Color fundus photograph. 45° FOV.
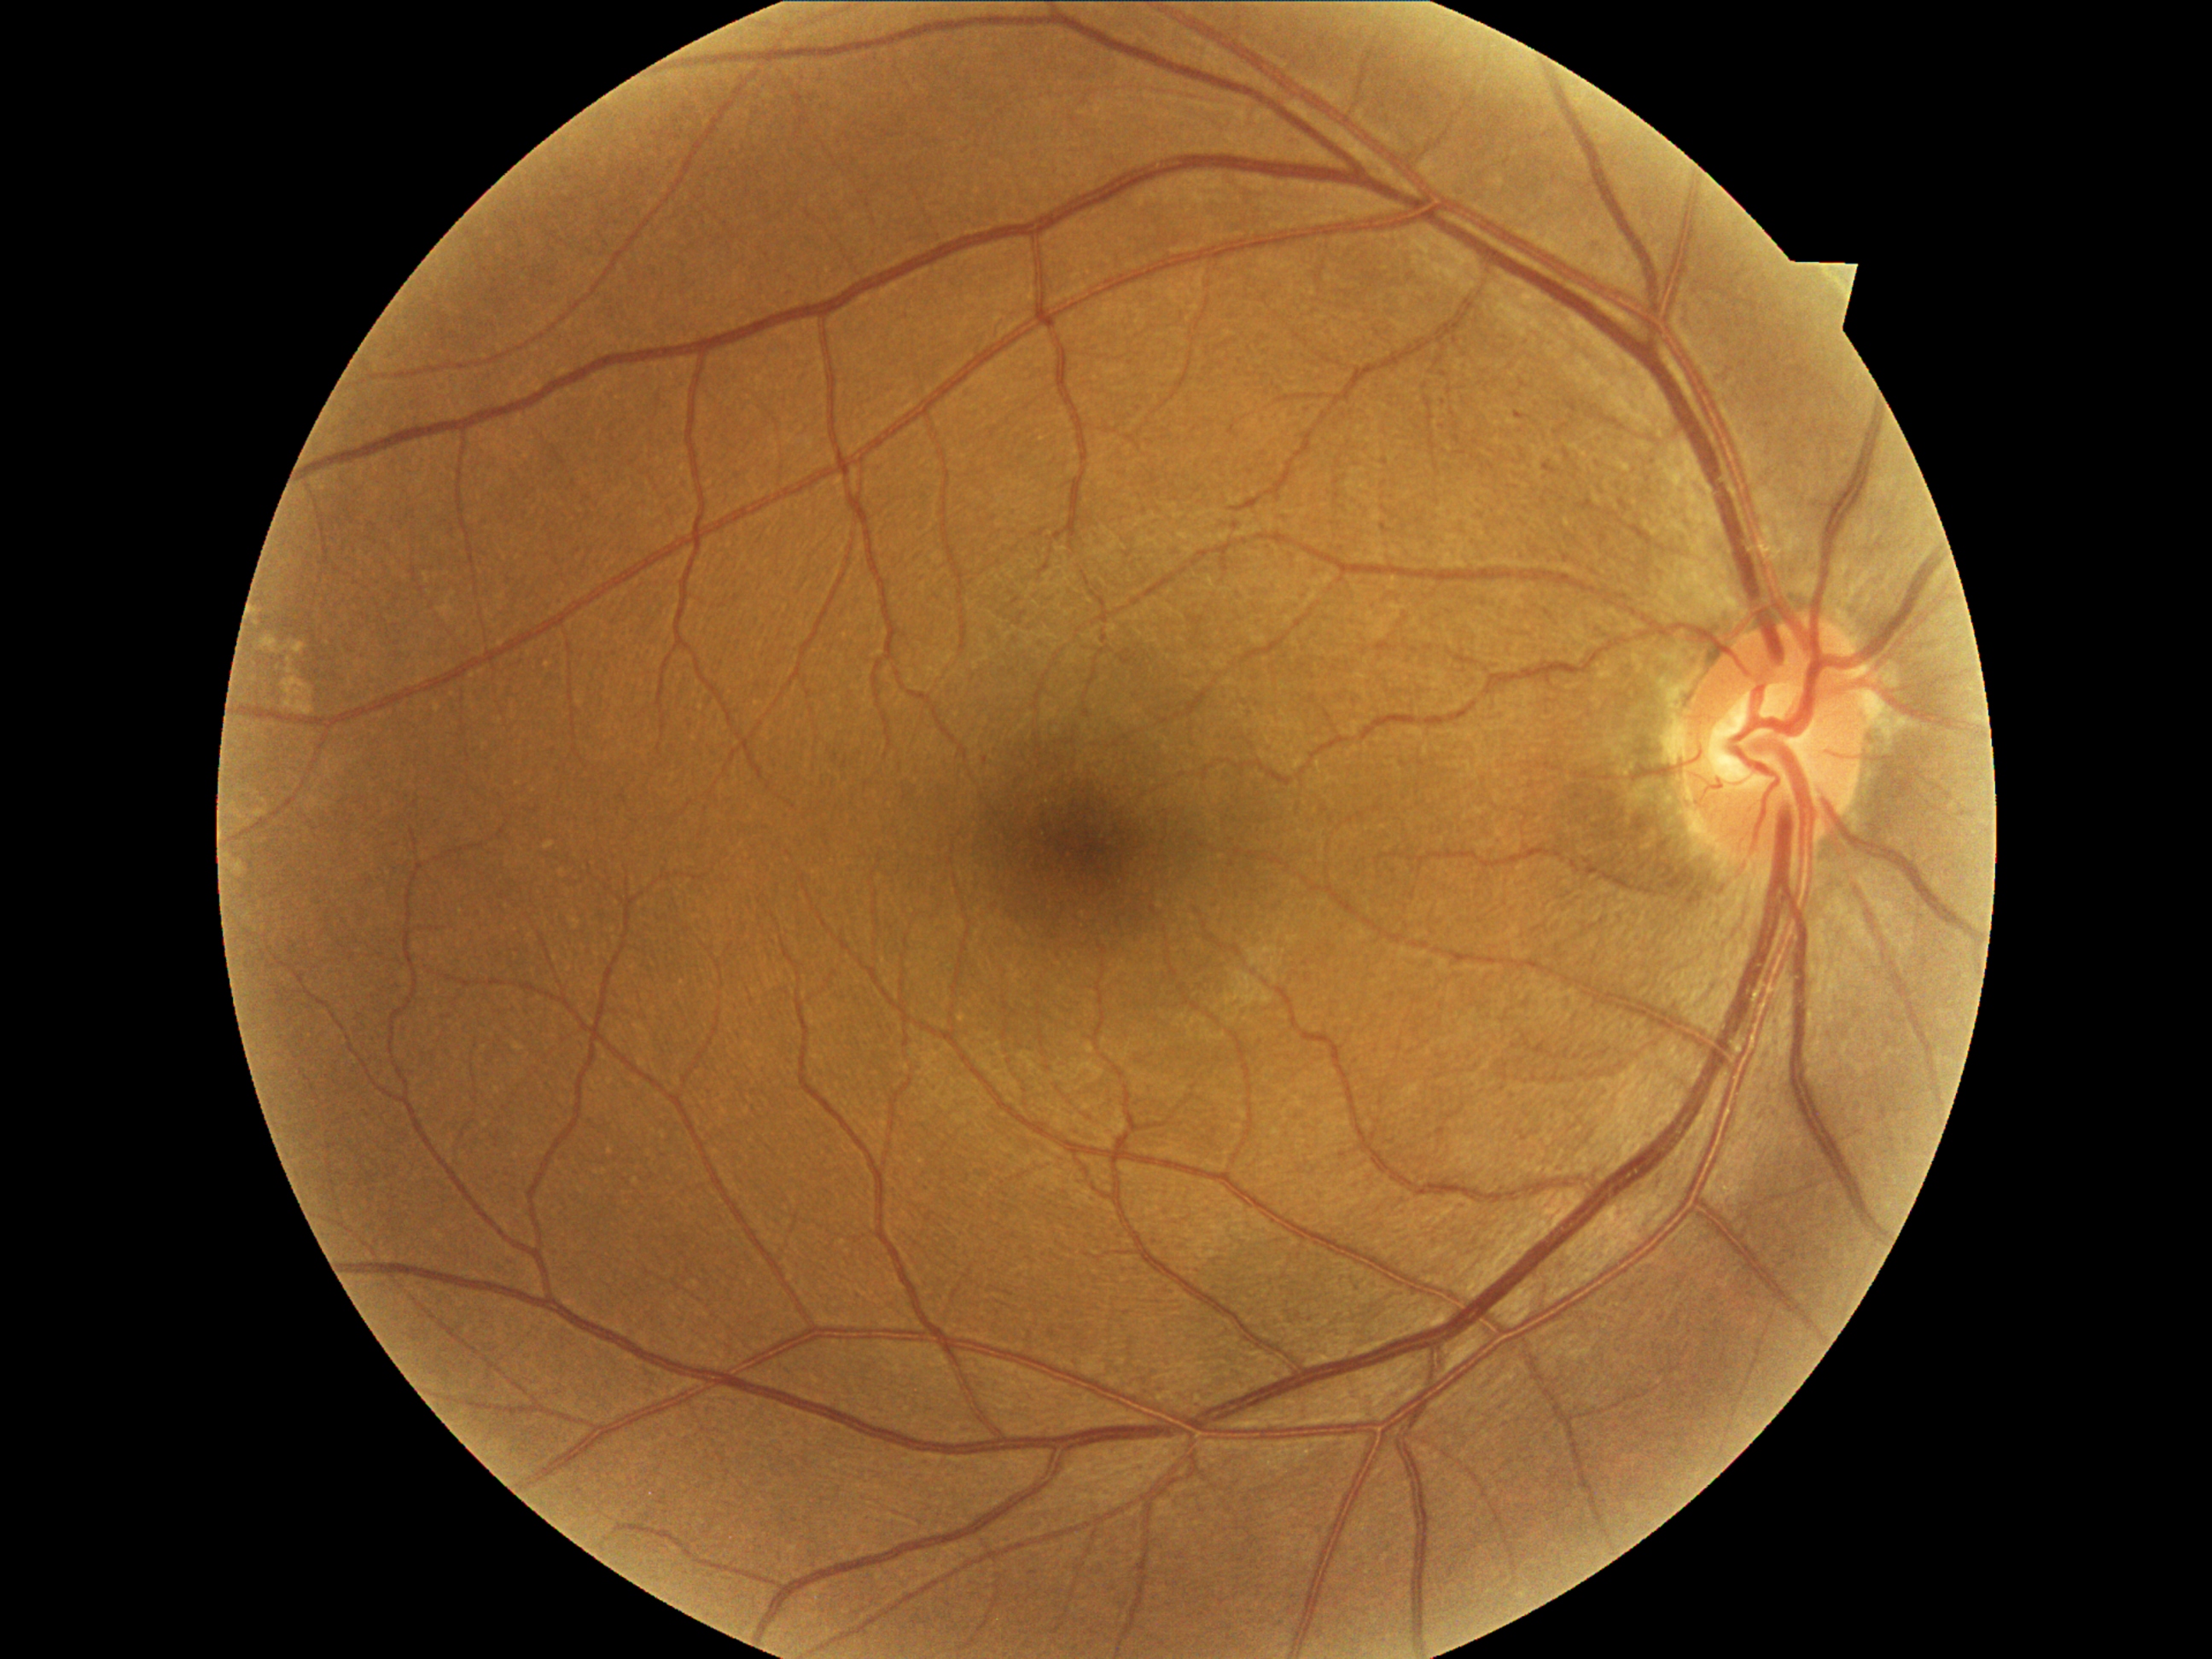

Diabetic retinopathy (DR) is 1.